2089 x 1764 pixels; CFP.
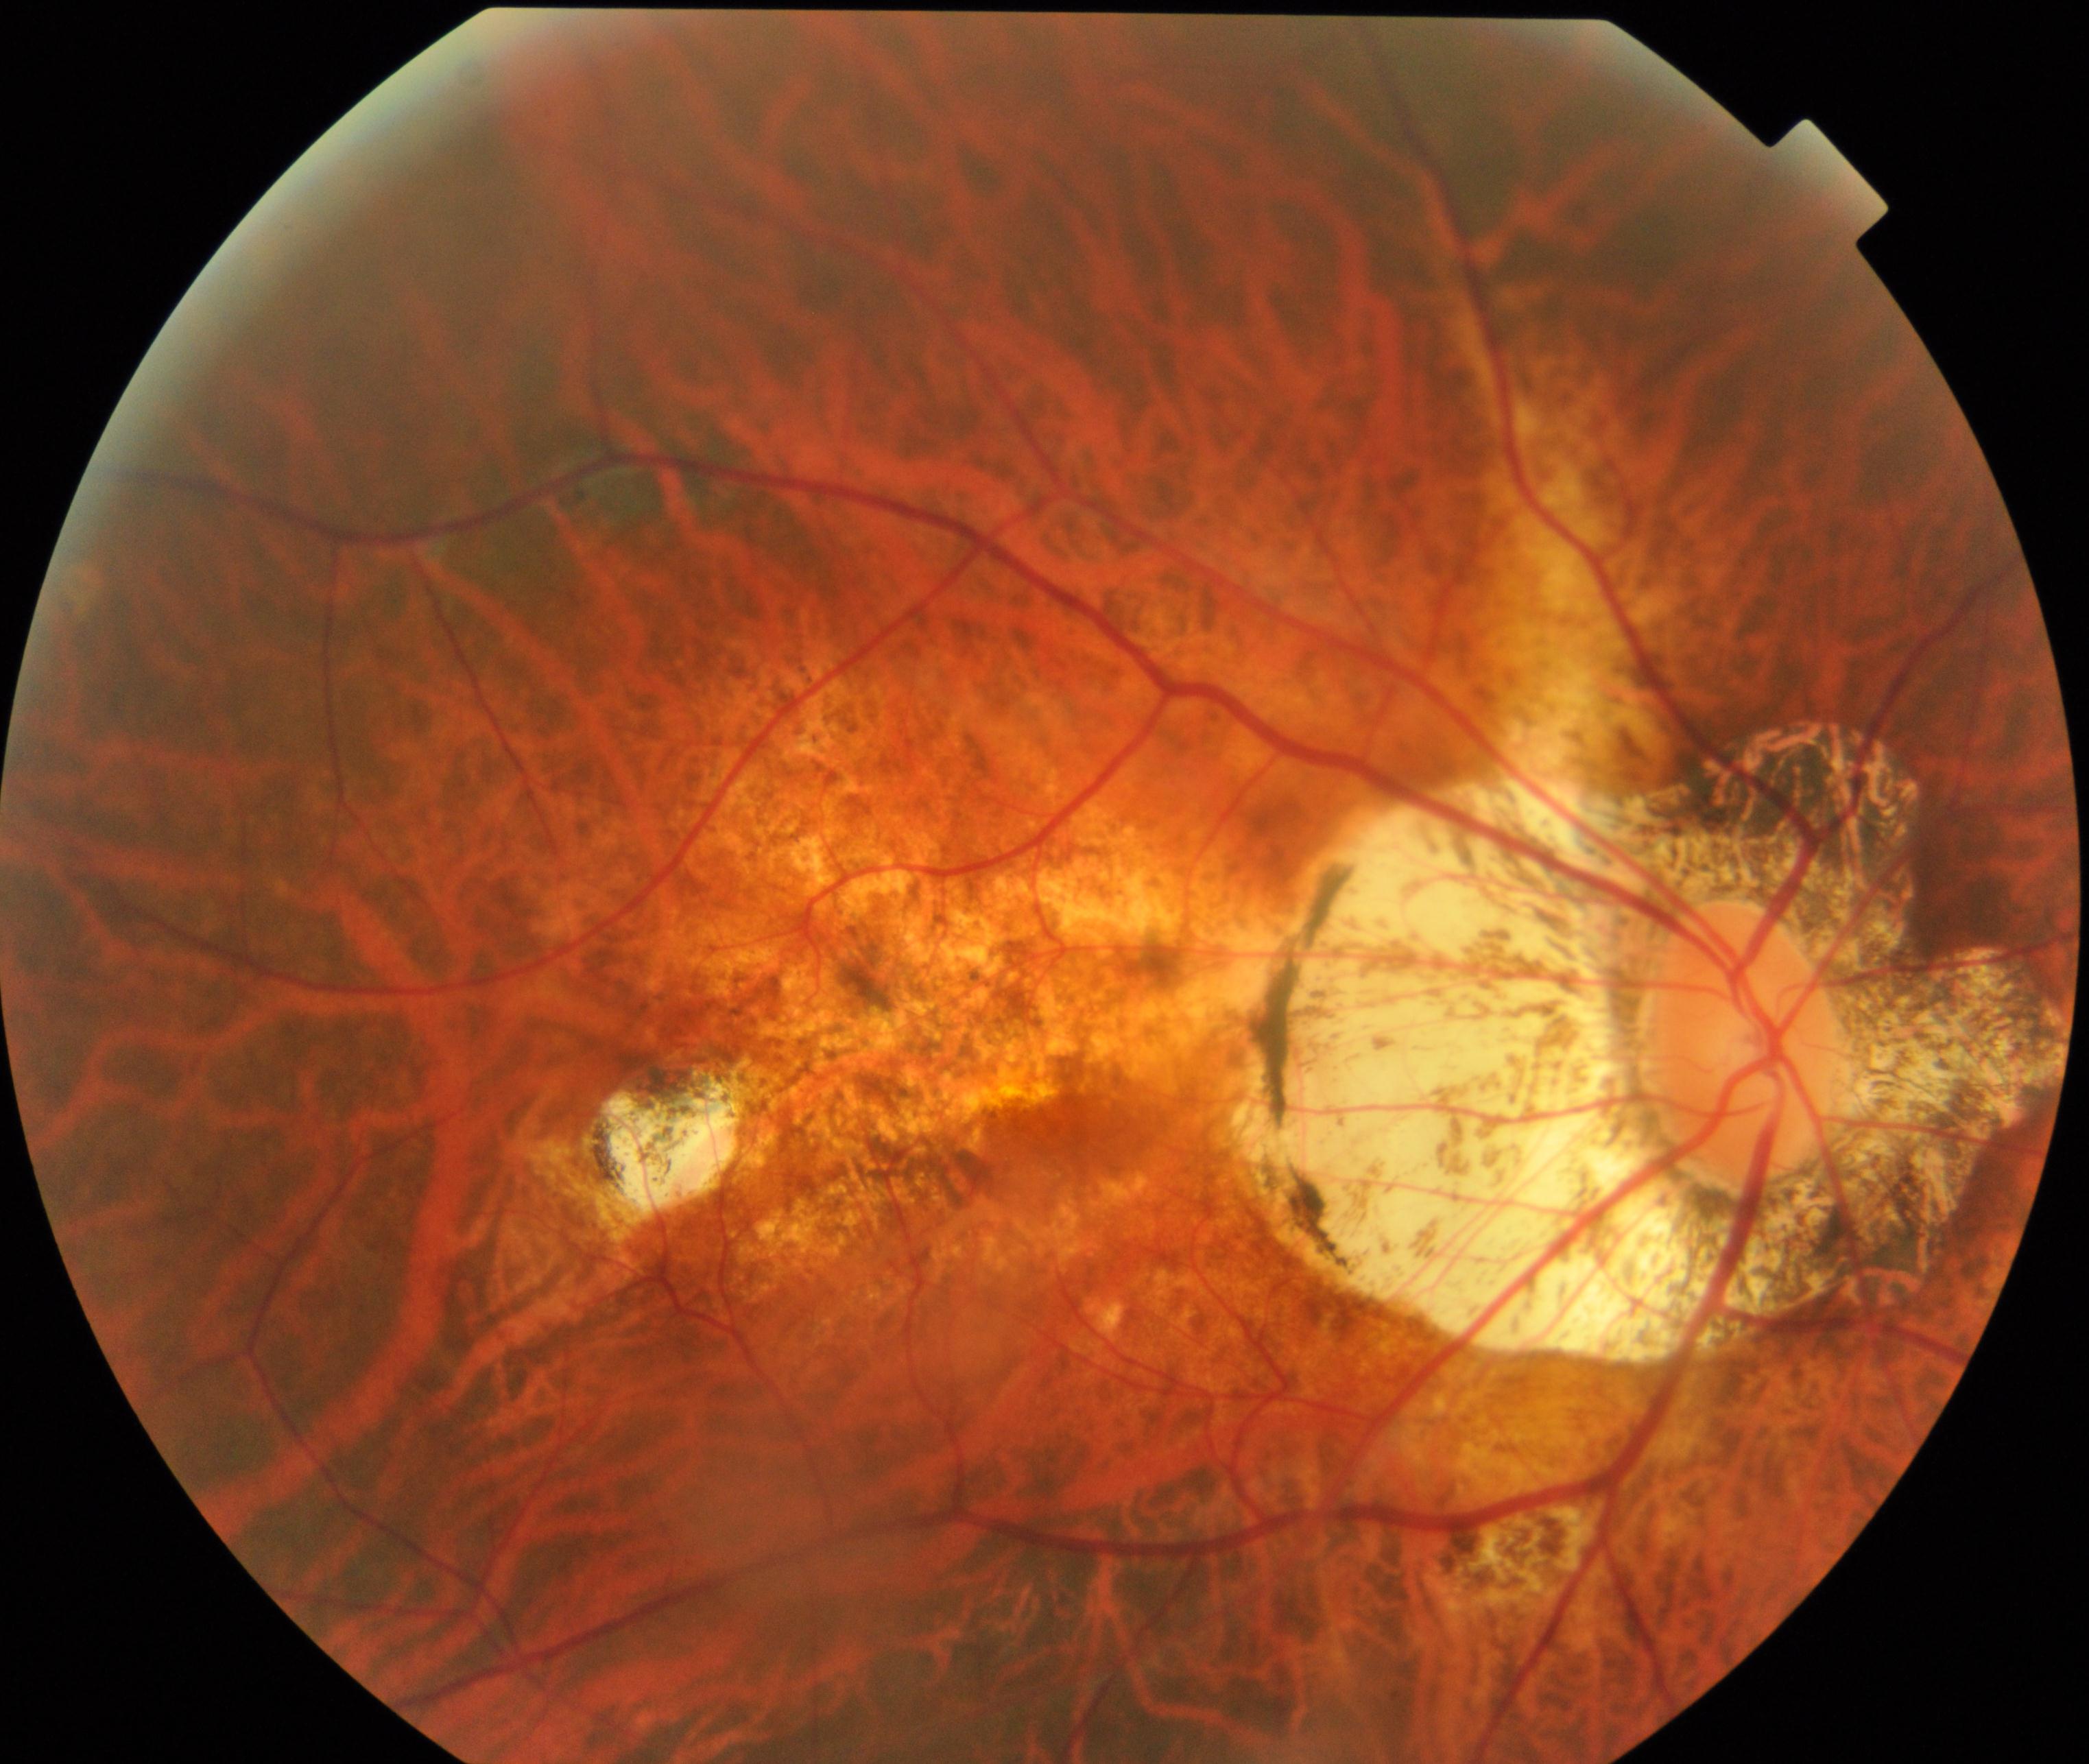 Demonstrates pathological myopia.